2089 by 1764 pixels · fundus photo — 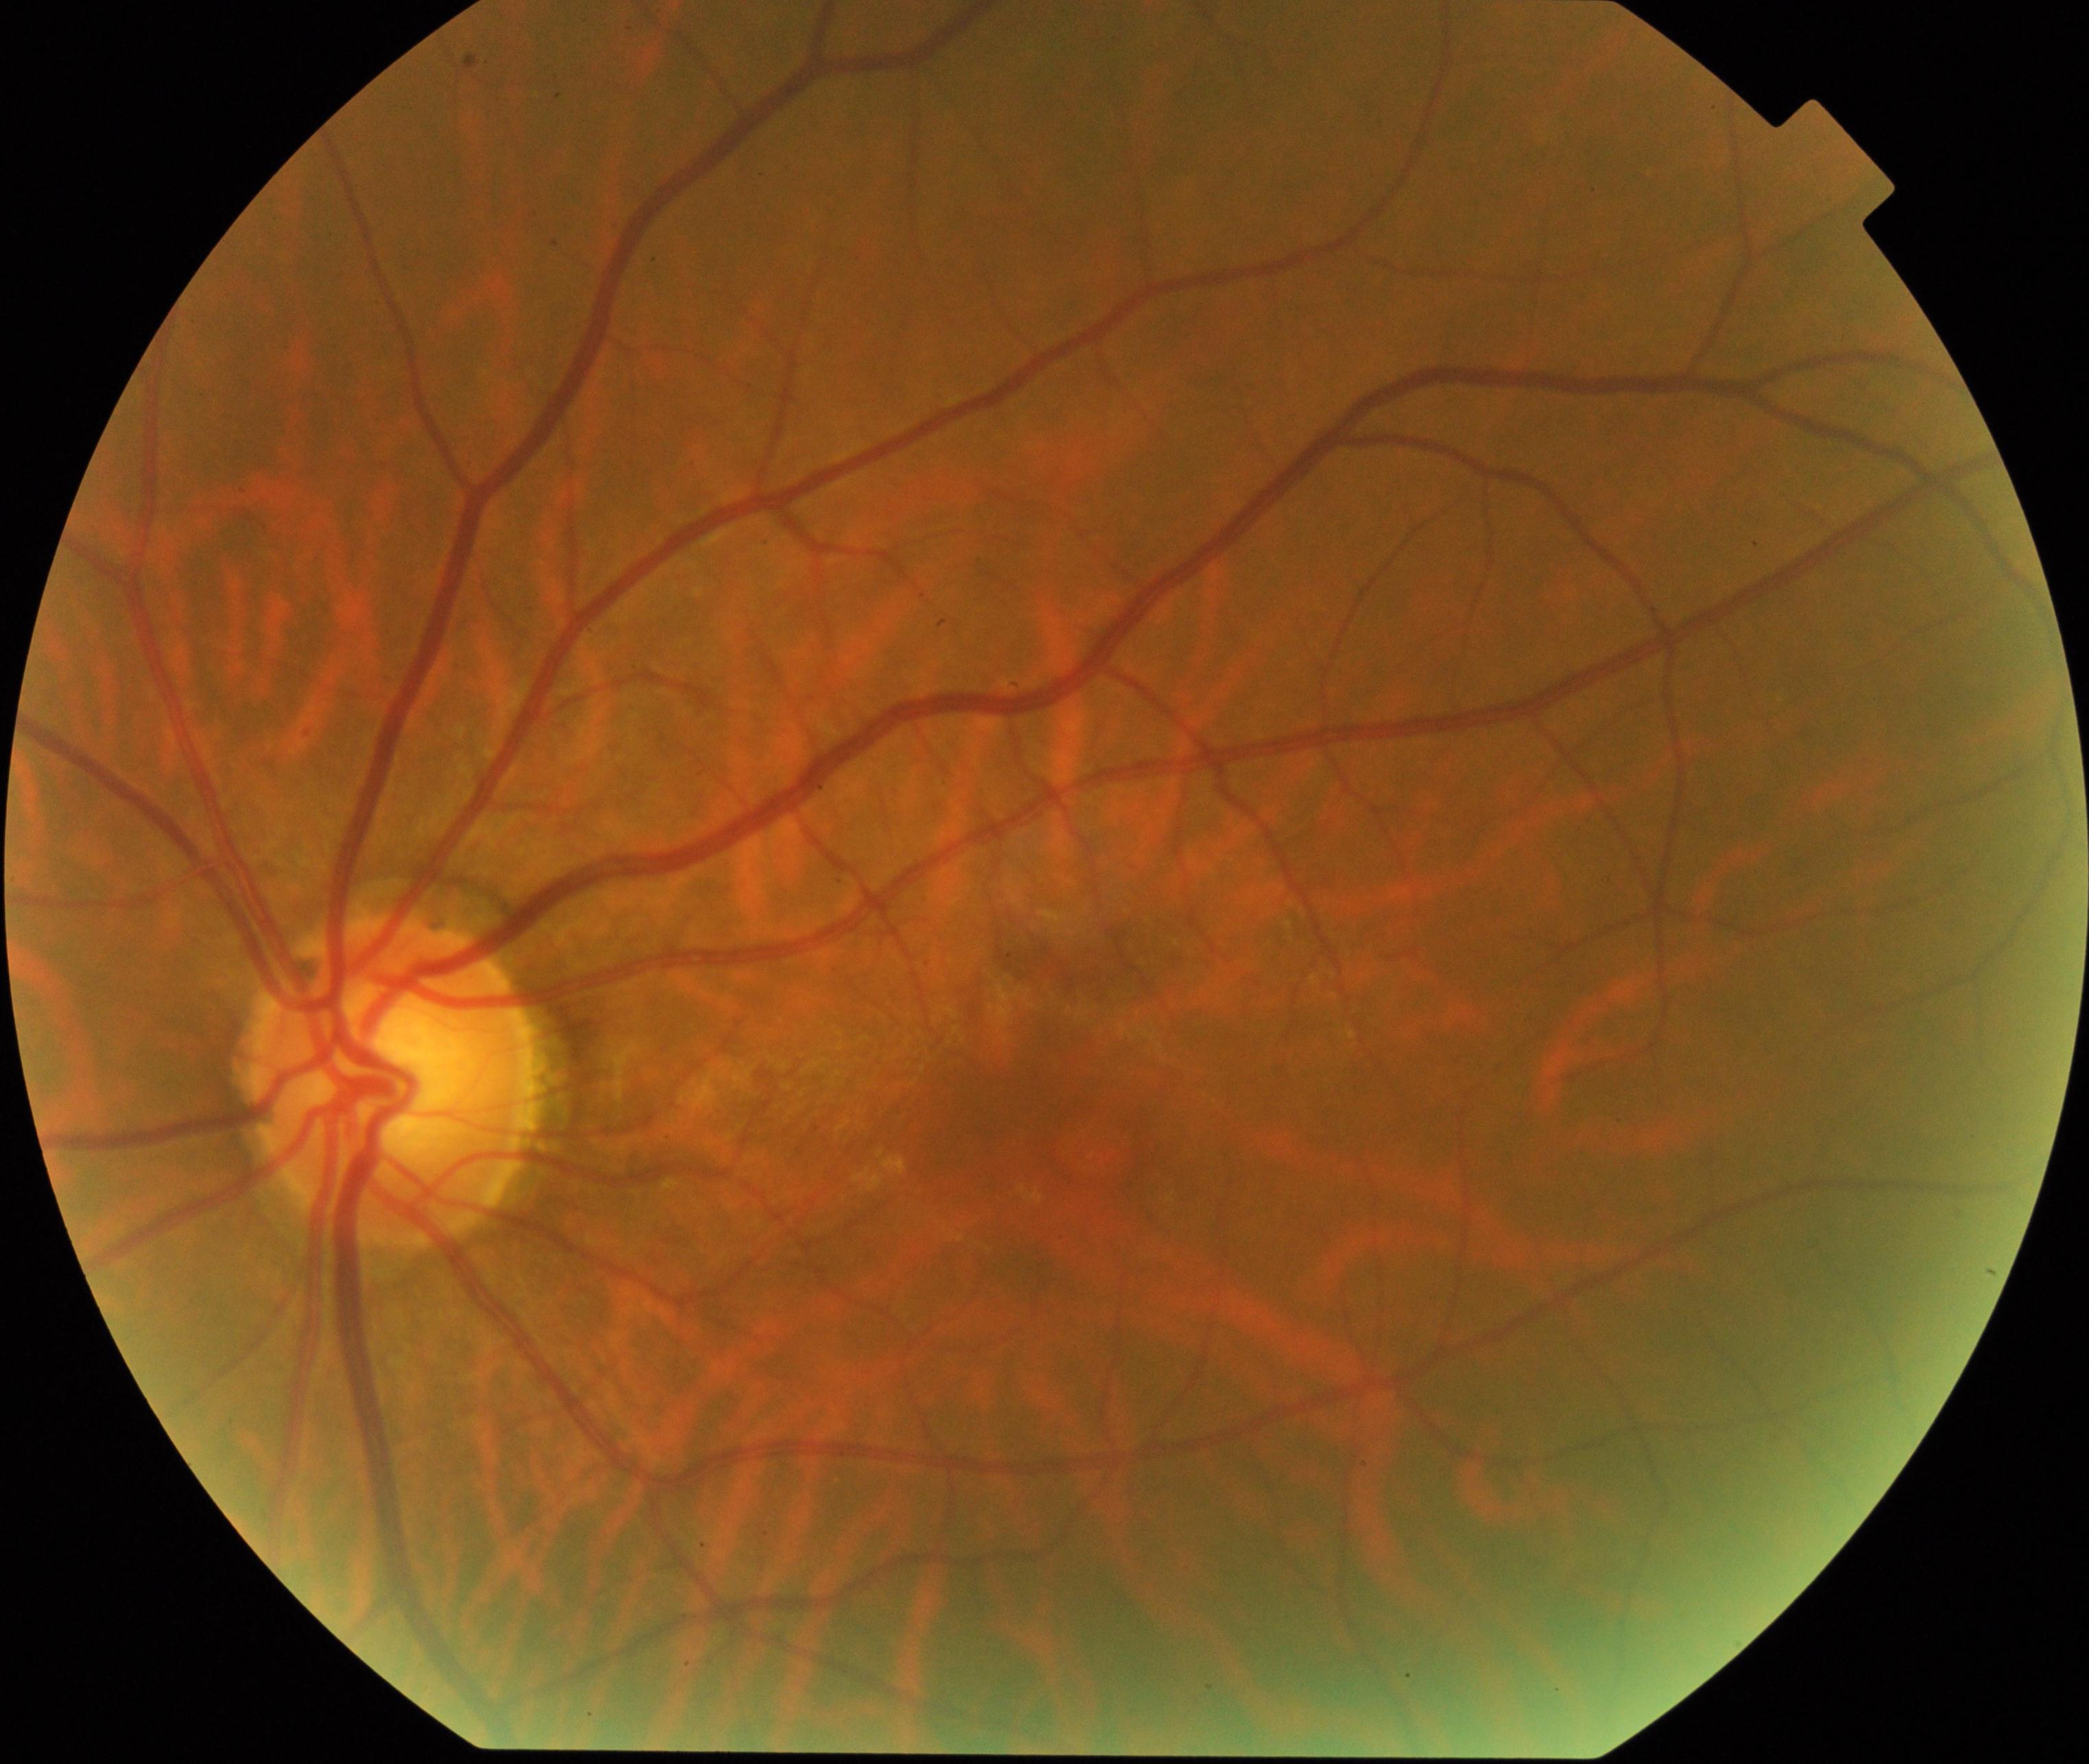 Findings consistent with epiretinal membrane.